Mydriatic (tropicamide and phenylephrine). 2228 by 1652 pixels. FOV: 50 degrees — 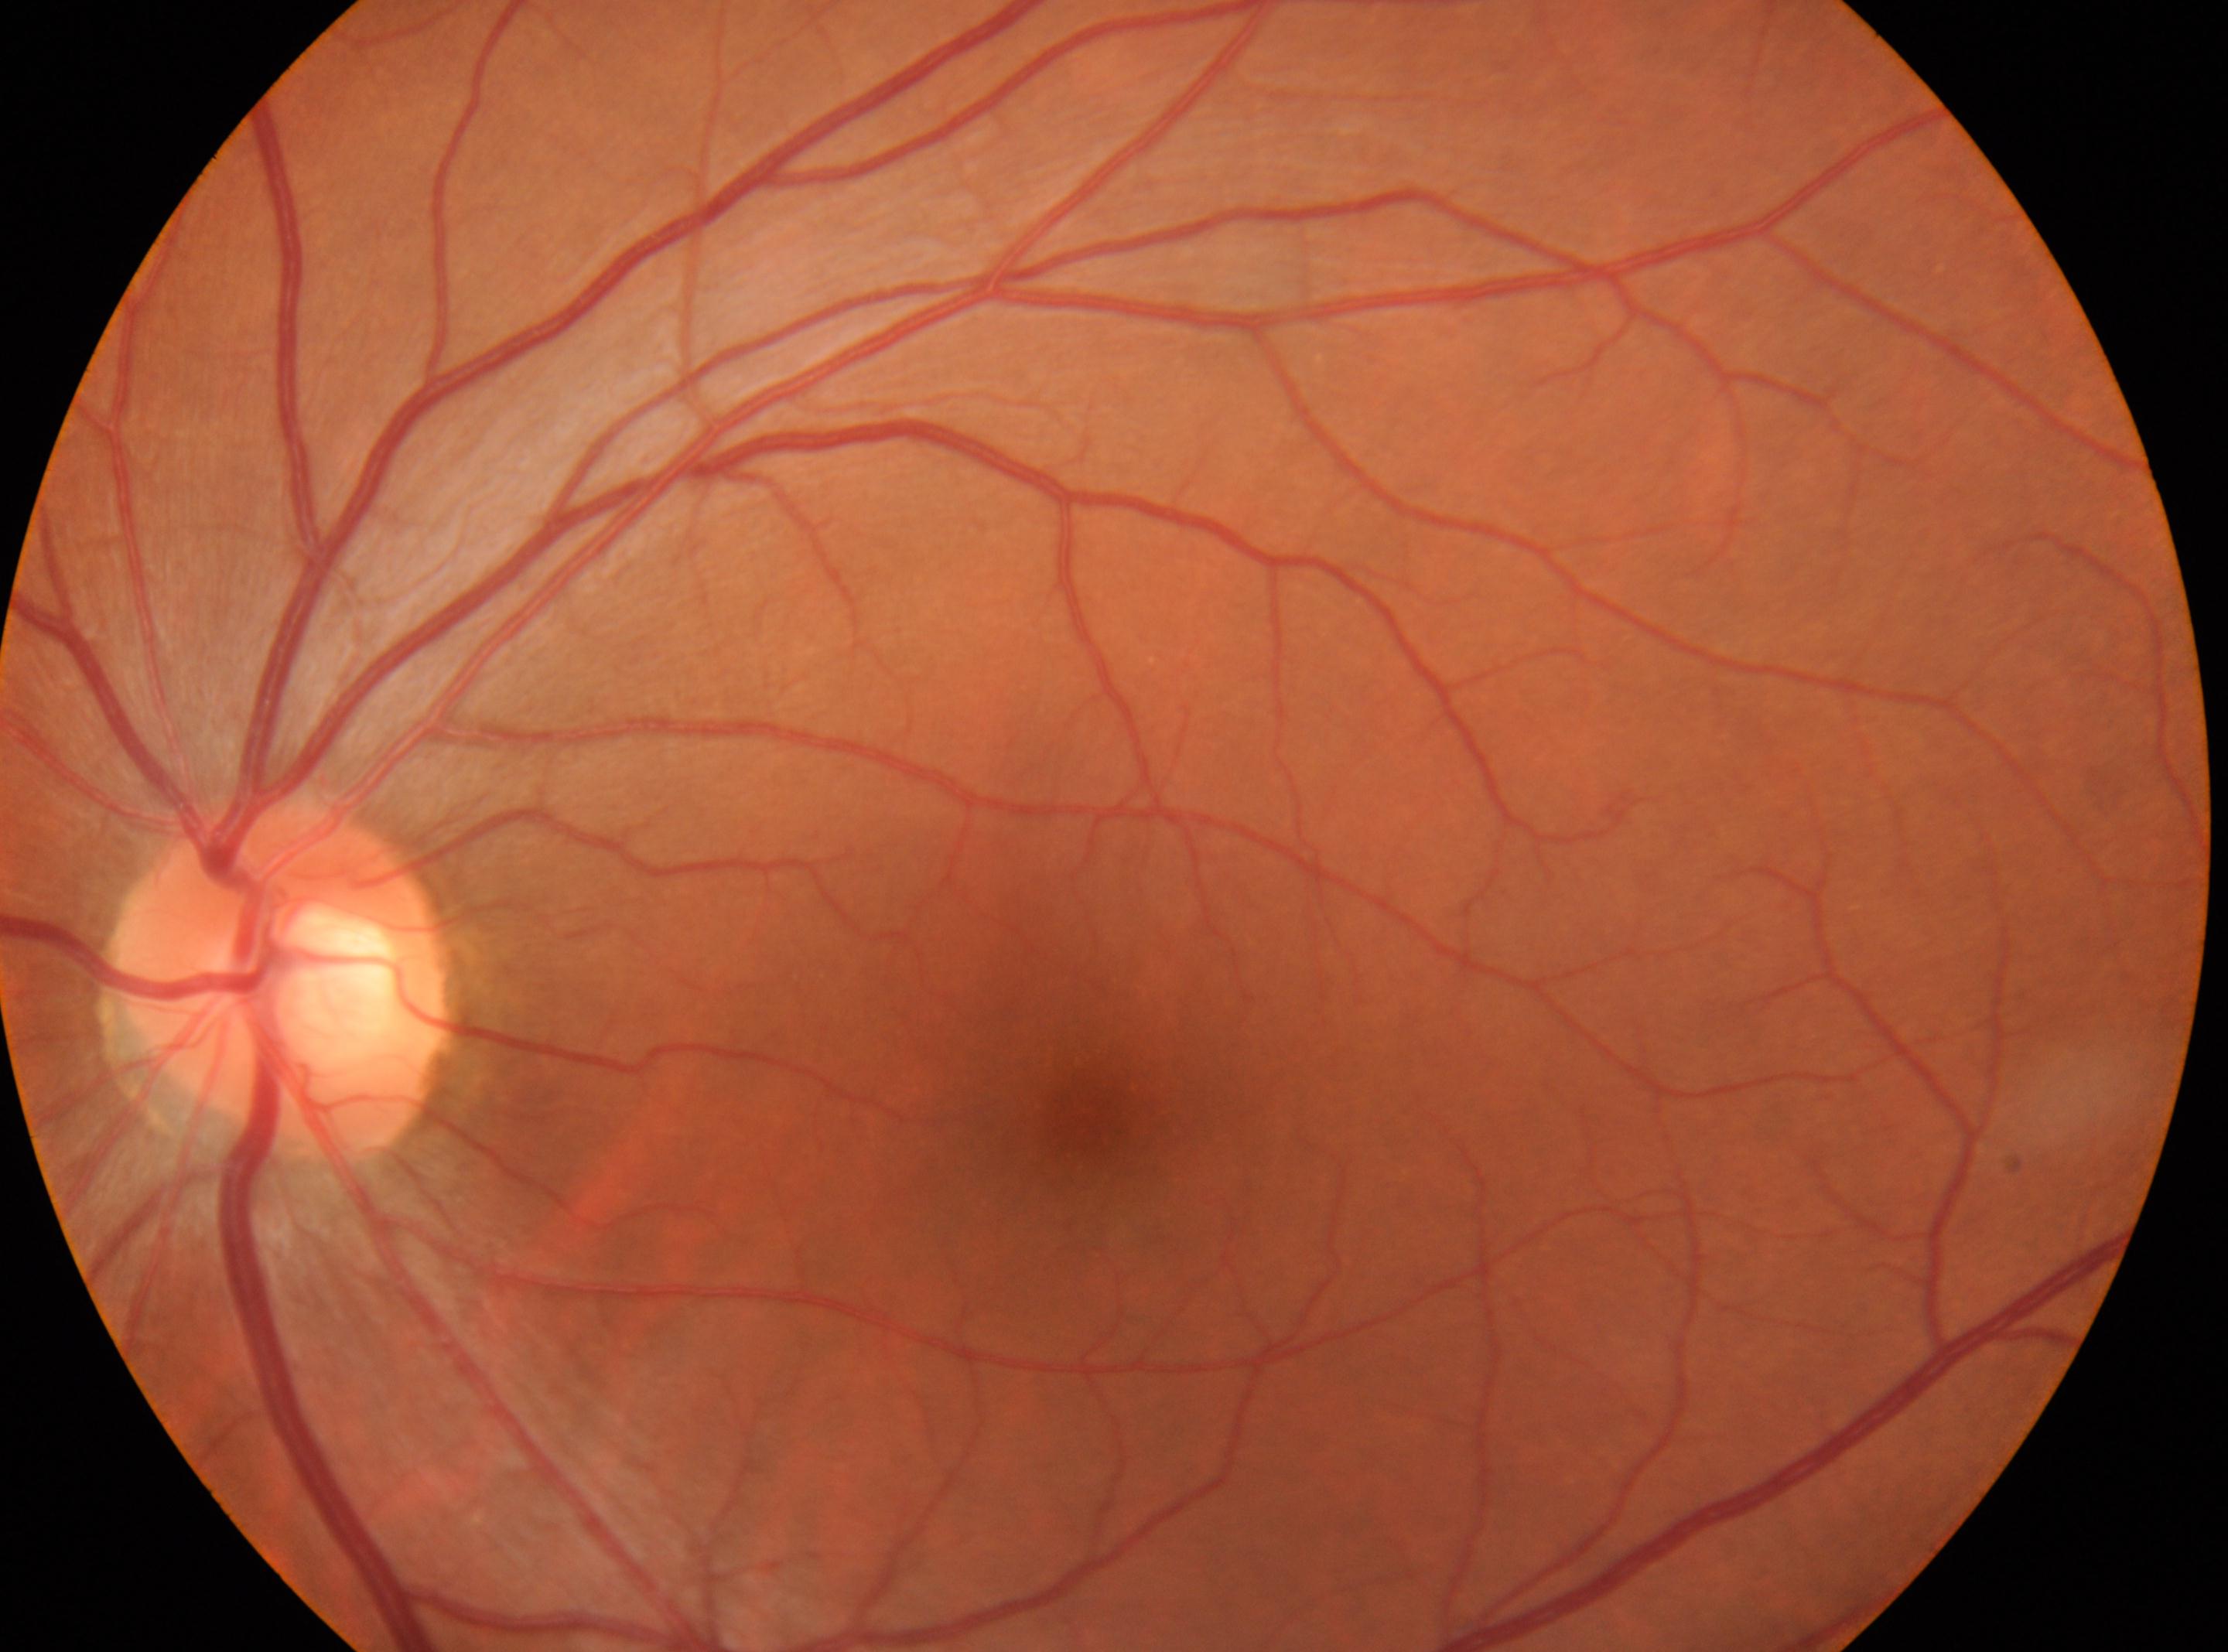
DR grade = no apparent diabetic retinopathy (0), fovea centralis = (1083,1121), optic disc = (282,981), laterality = left eye.